Posterior pole photograph. Nonmydriatic fundus photograph. Image size 848x848. Diabetic retinopathy graded by the modified Davis classification. 45° field of view — 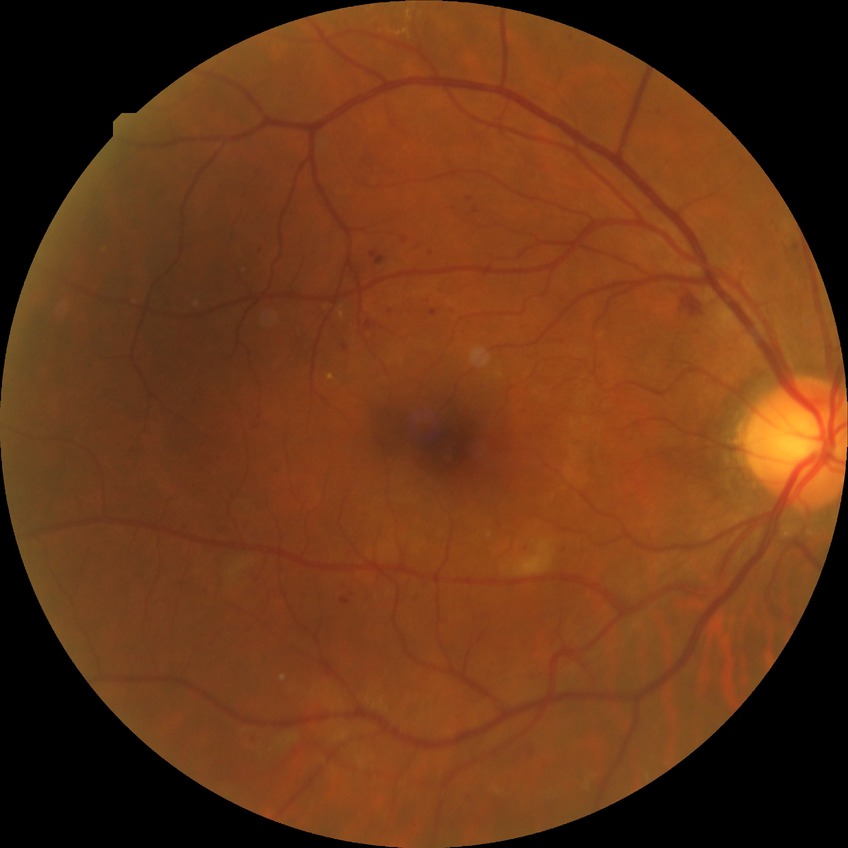

diabetic retinopathy grade: simple diabetic retinopathy
DR class: non-proliferative diabetic retinopathy